1240x1240 · wide-field fundus photograph from neonatal ROP screening · 100° field of view (Phoenix ICON) — 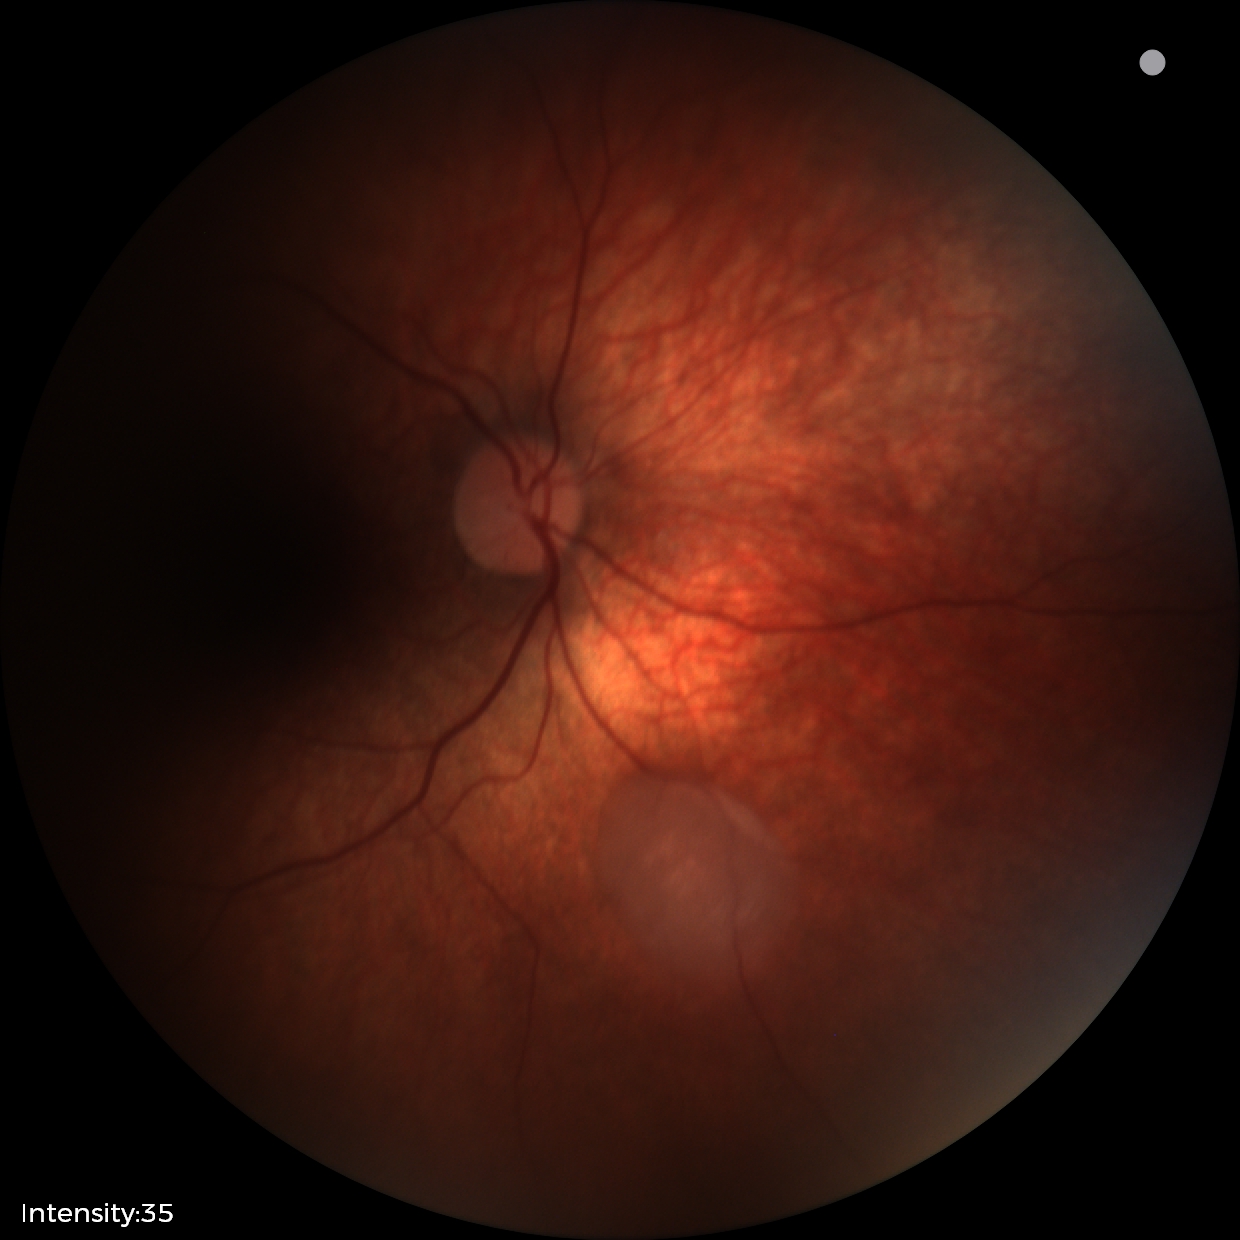
Impression: retinal astrocytic hamartoma.